Patient age: 73 years. Axial length (AL): 24.14 mm. Sex: F: 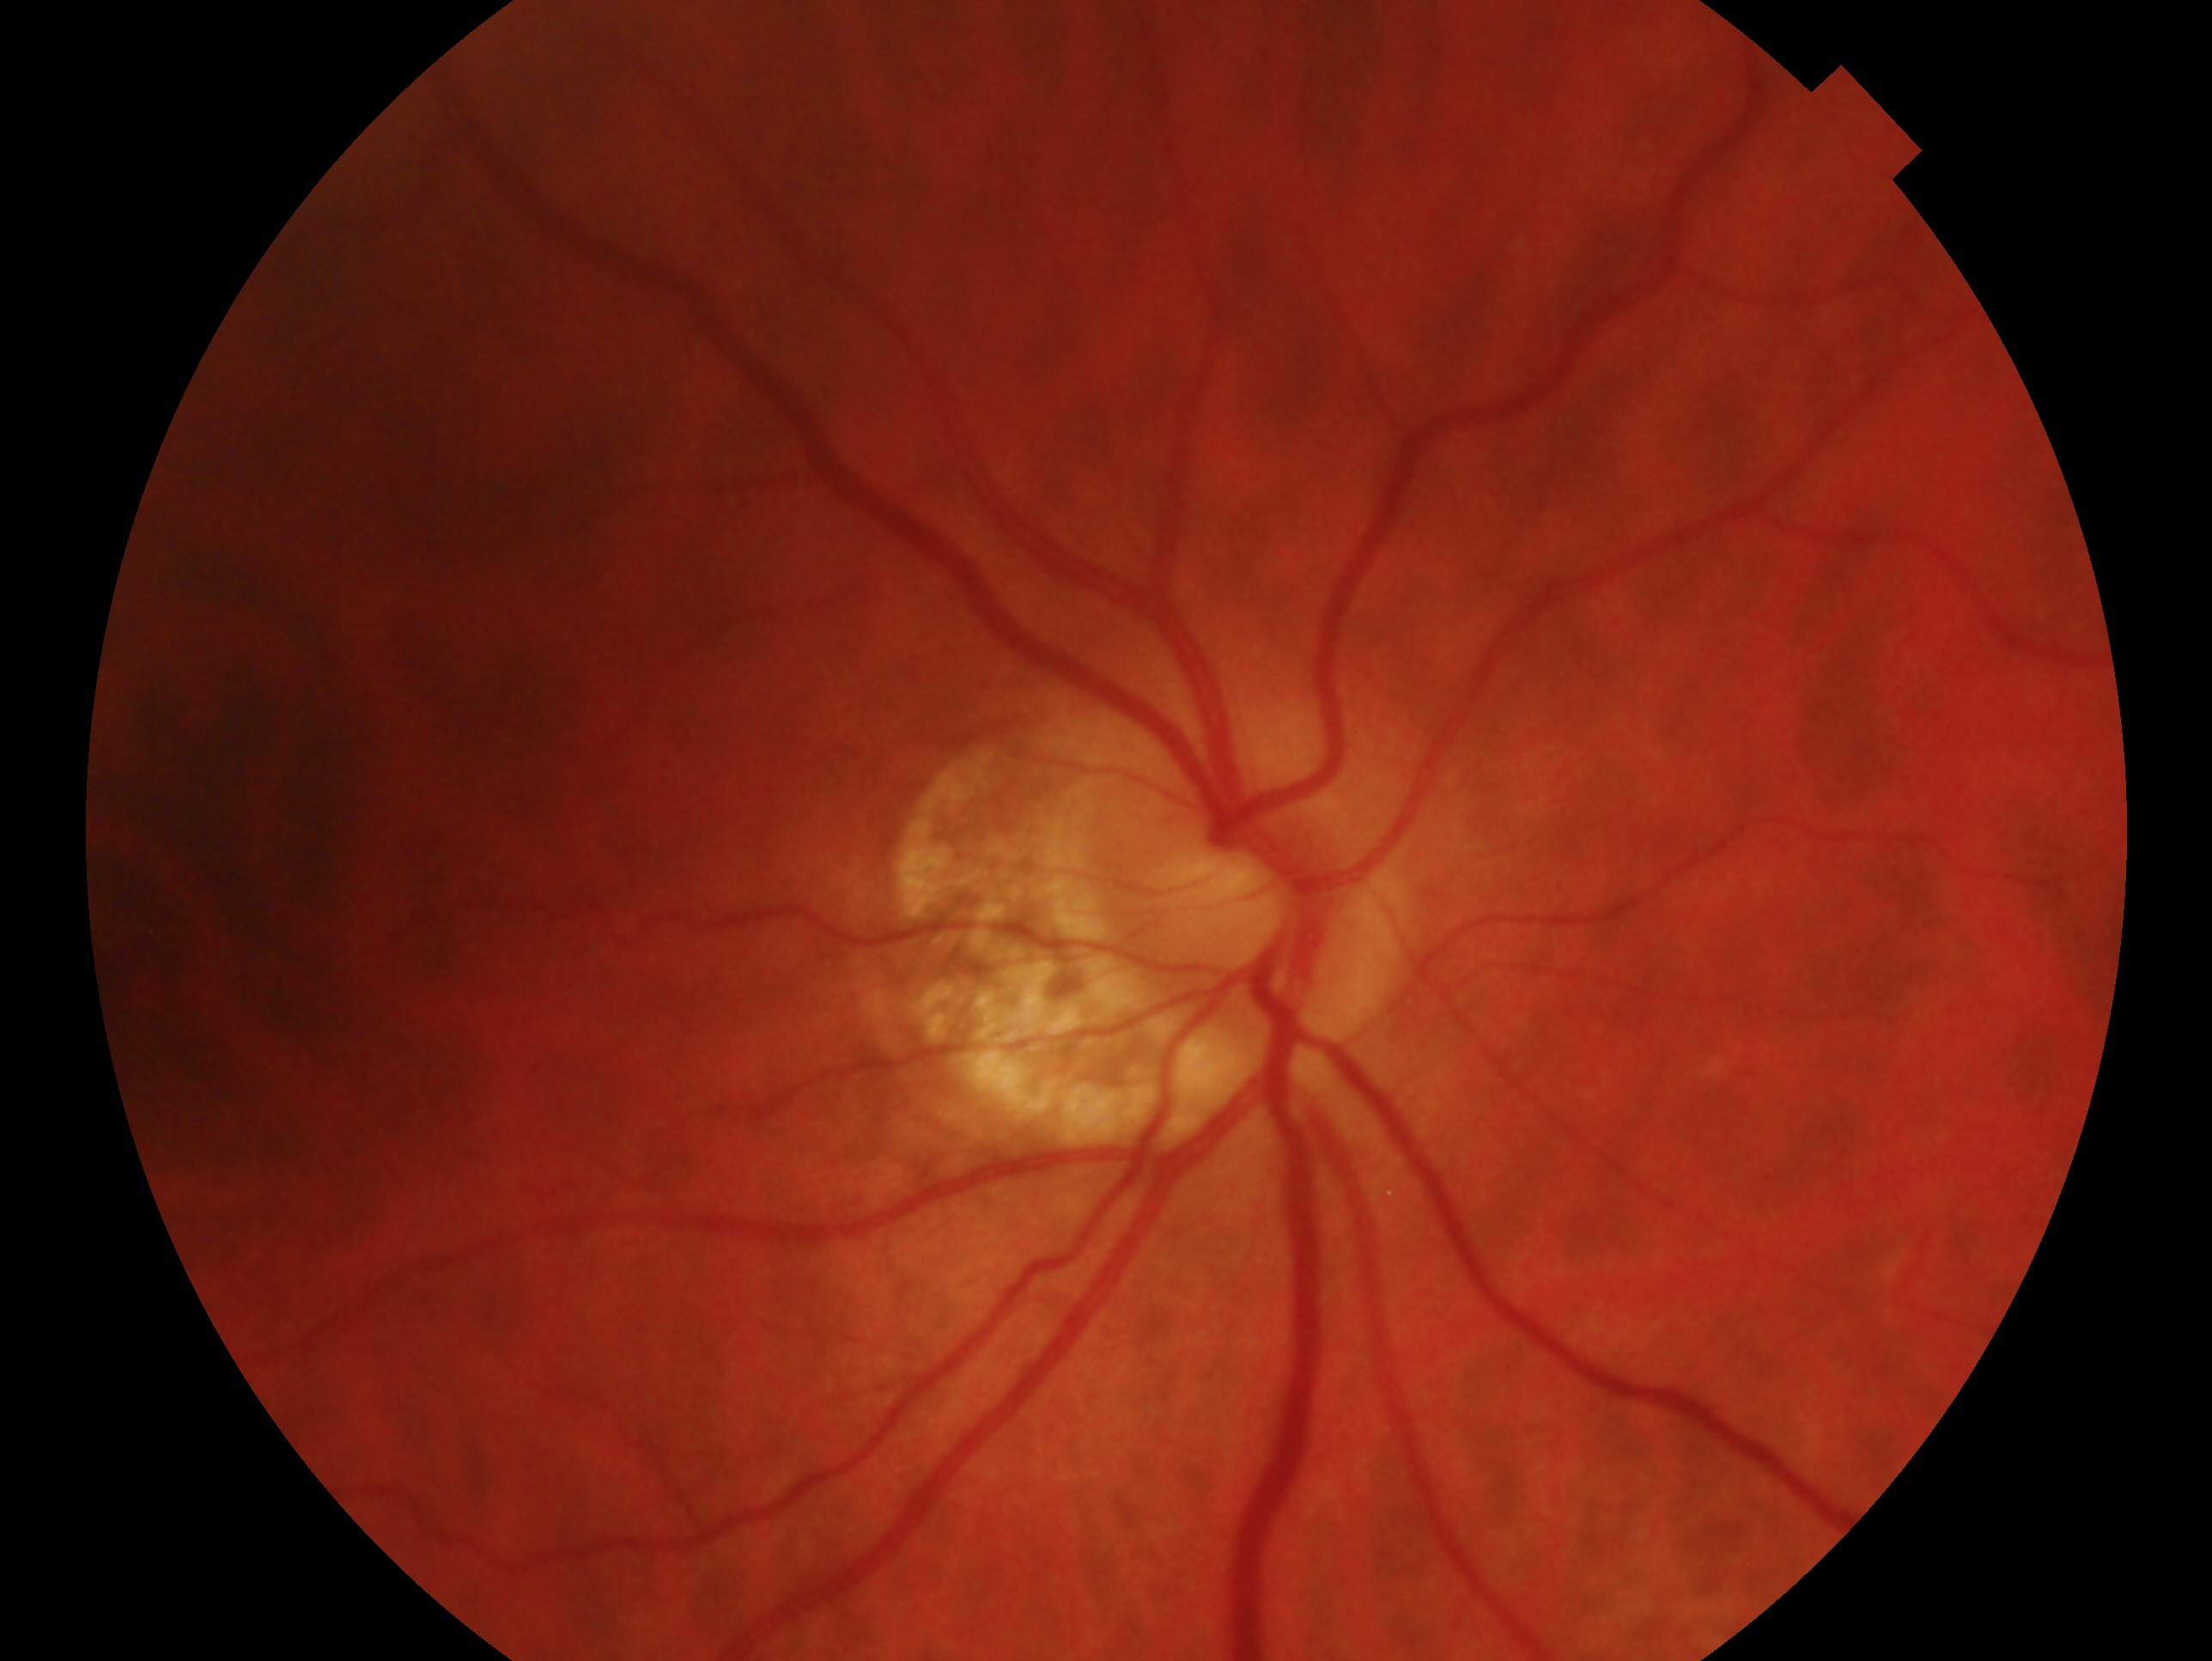

Diagnosis — no evidence of glaucoma. This is the OD.